1240x1240px · infant wide-field retinal image · acquired on the Phoenix ICON:
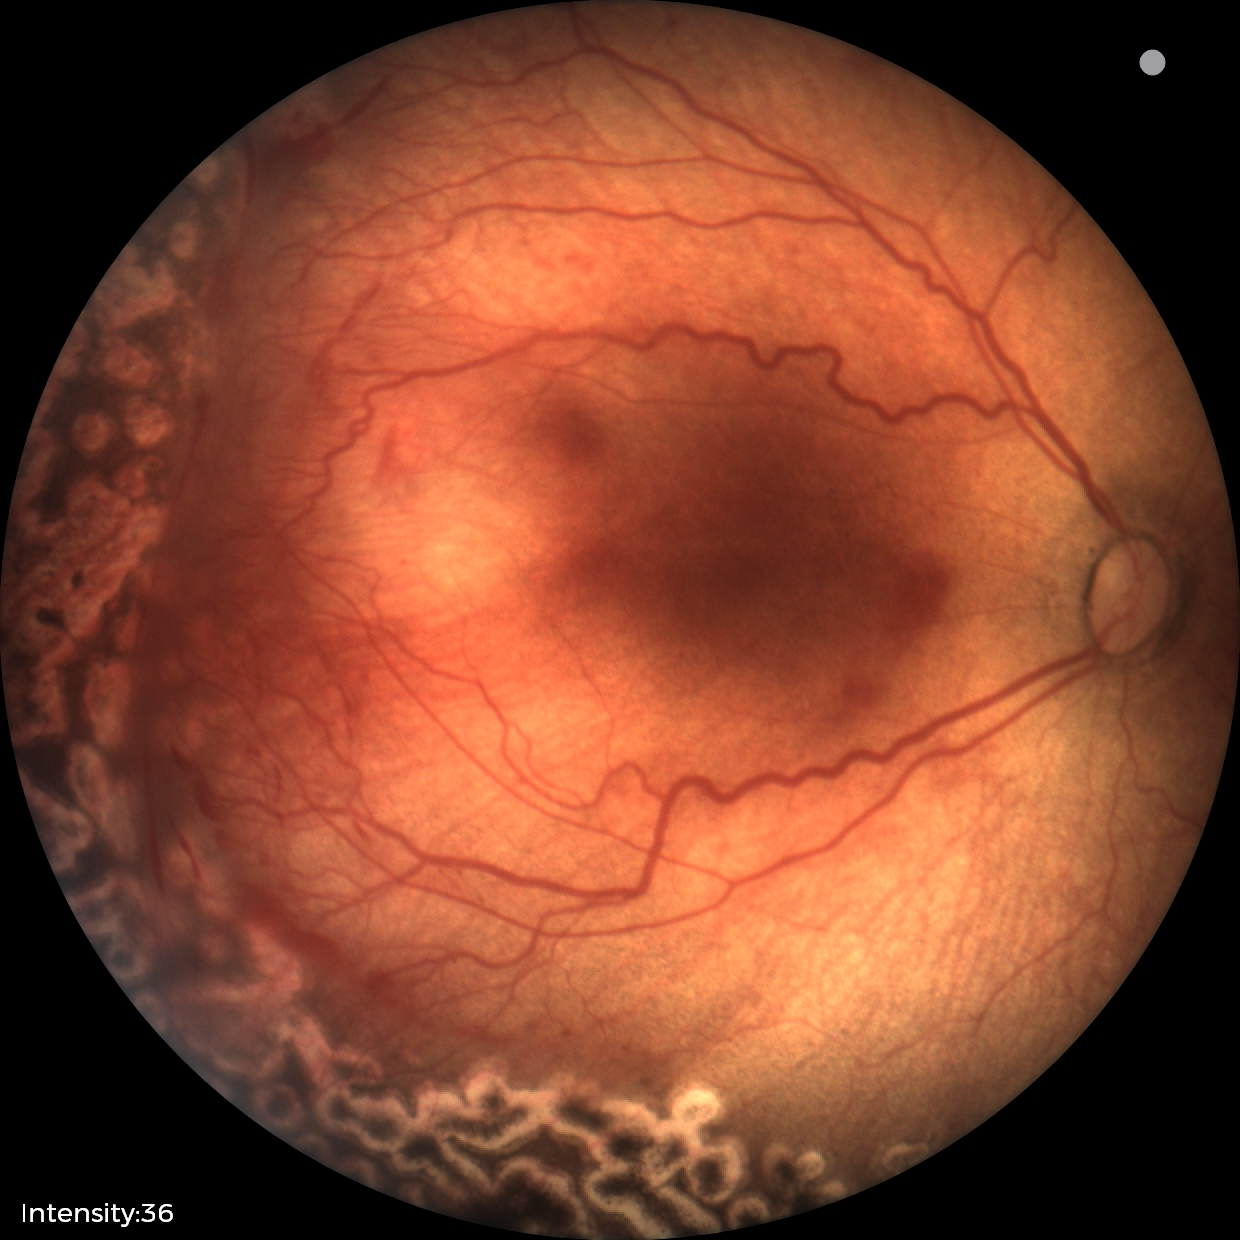

Screening: no plus disease | status post retinopathy of prematurity.